Camera: NIDEK AFC-230; 848x848; retinal fundus photograph; no pharmacologic dilation
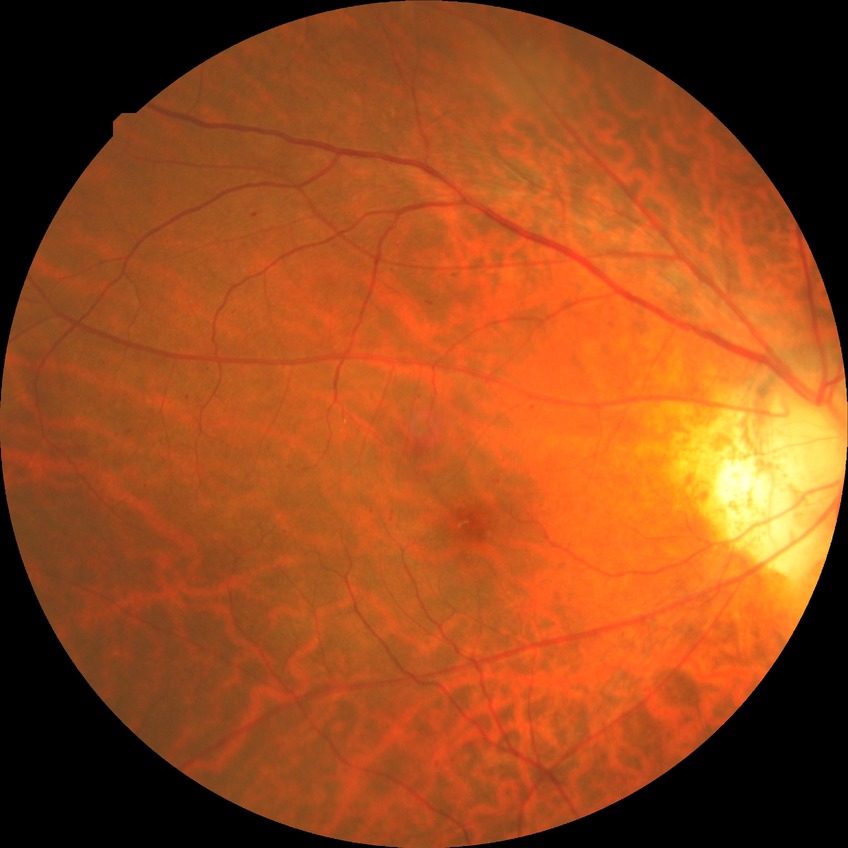
Diabetic retinopathy severity: simple diabetic retinopathy.